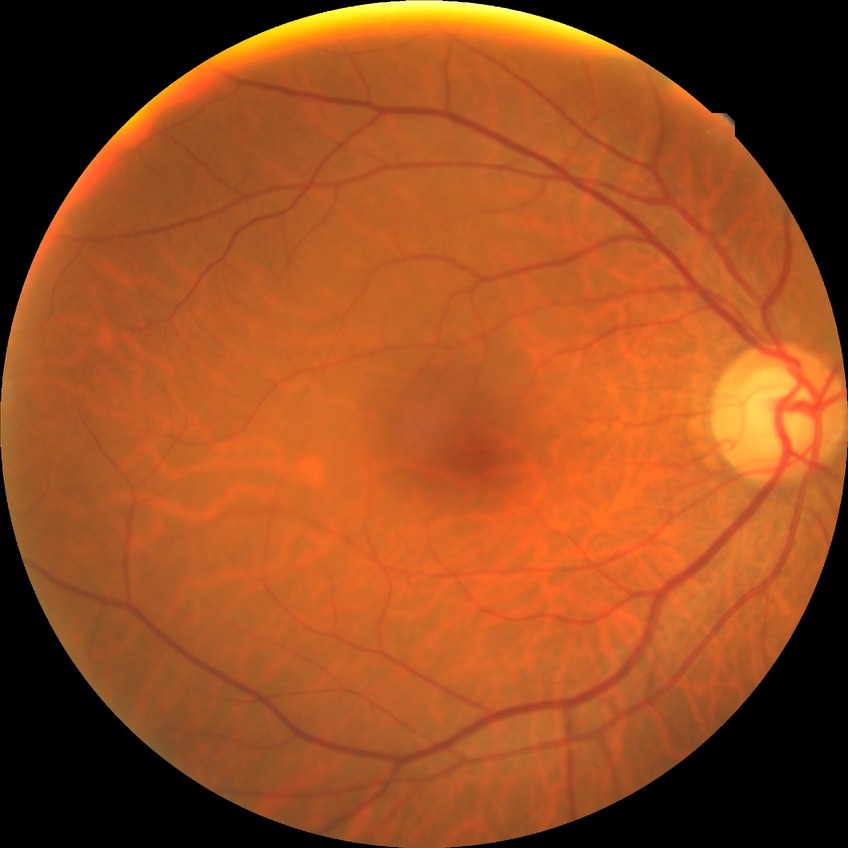 Diabetic retinopathy stage: no diabetic retinopathy.